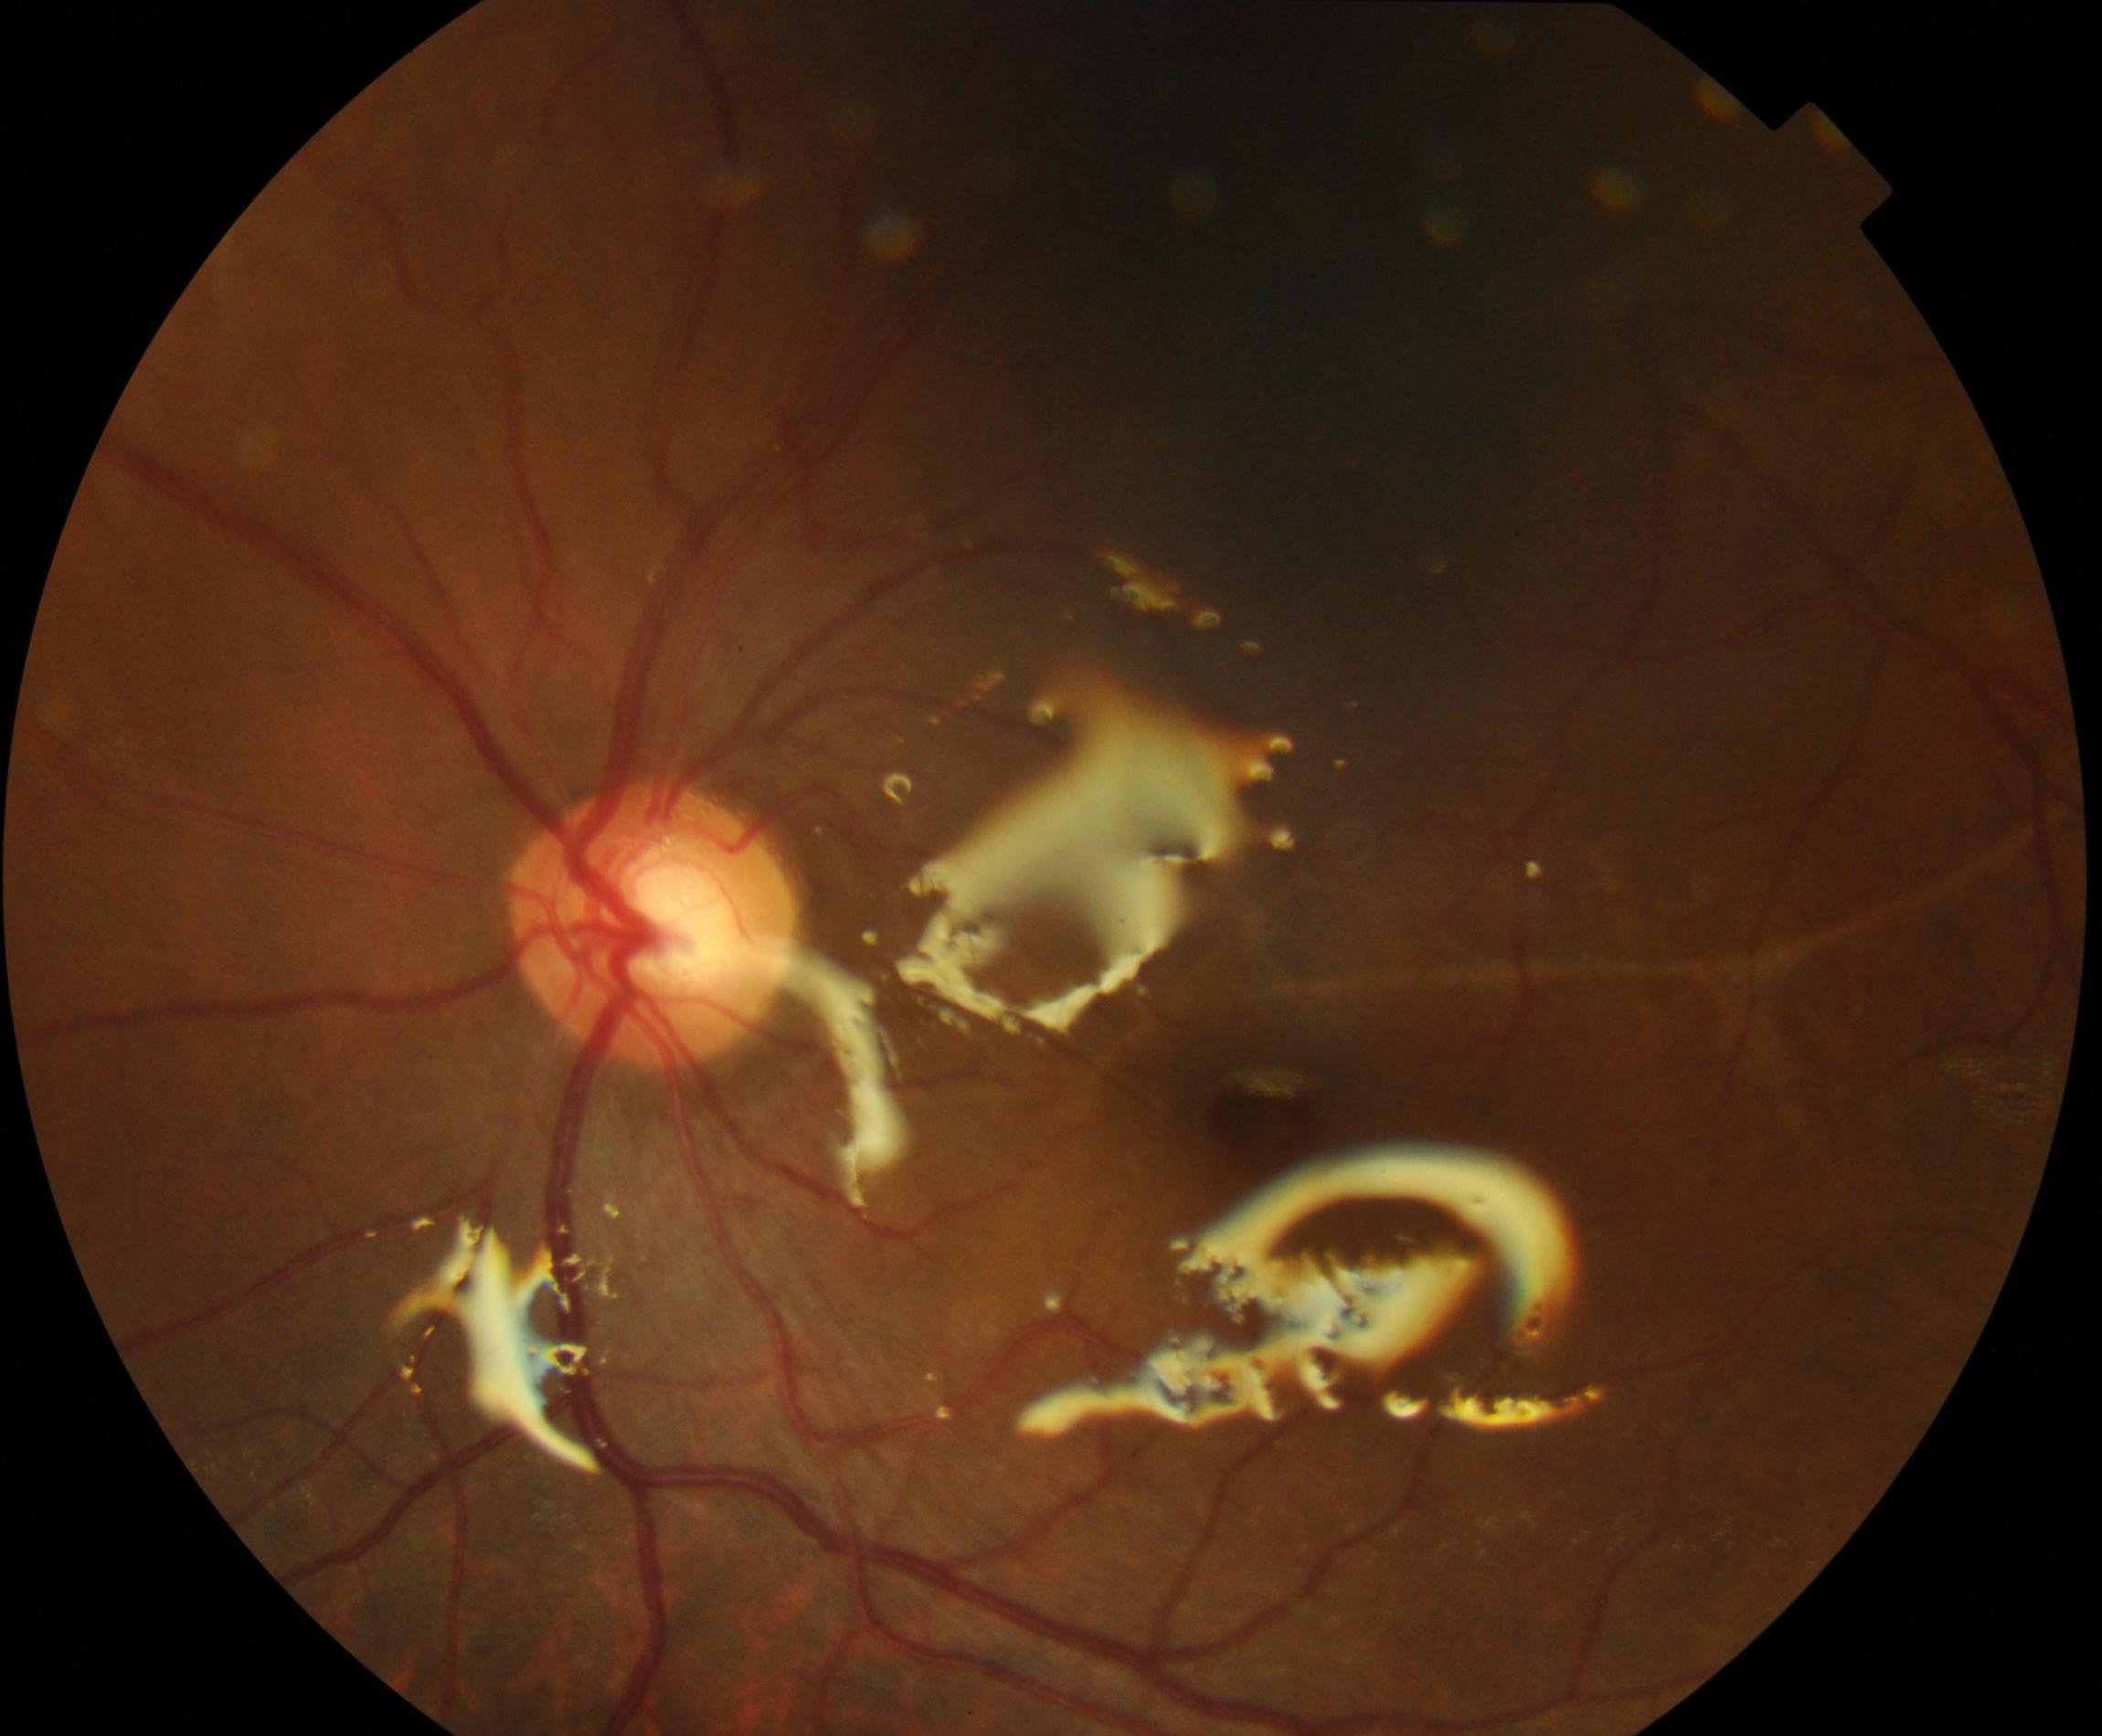 Impression: silicone oil in the eye.